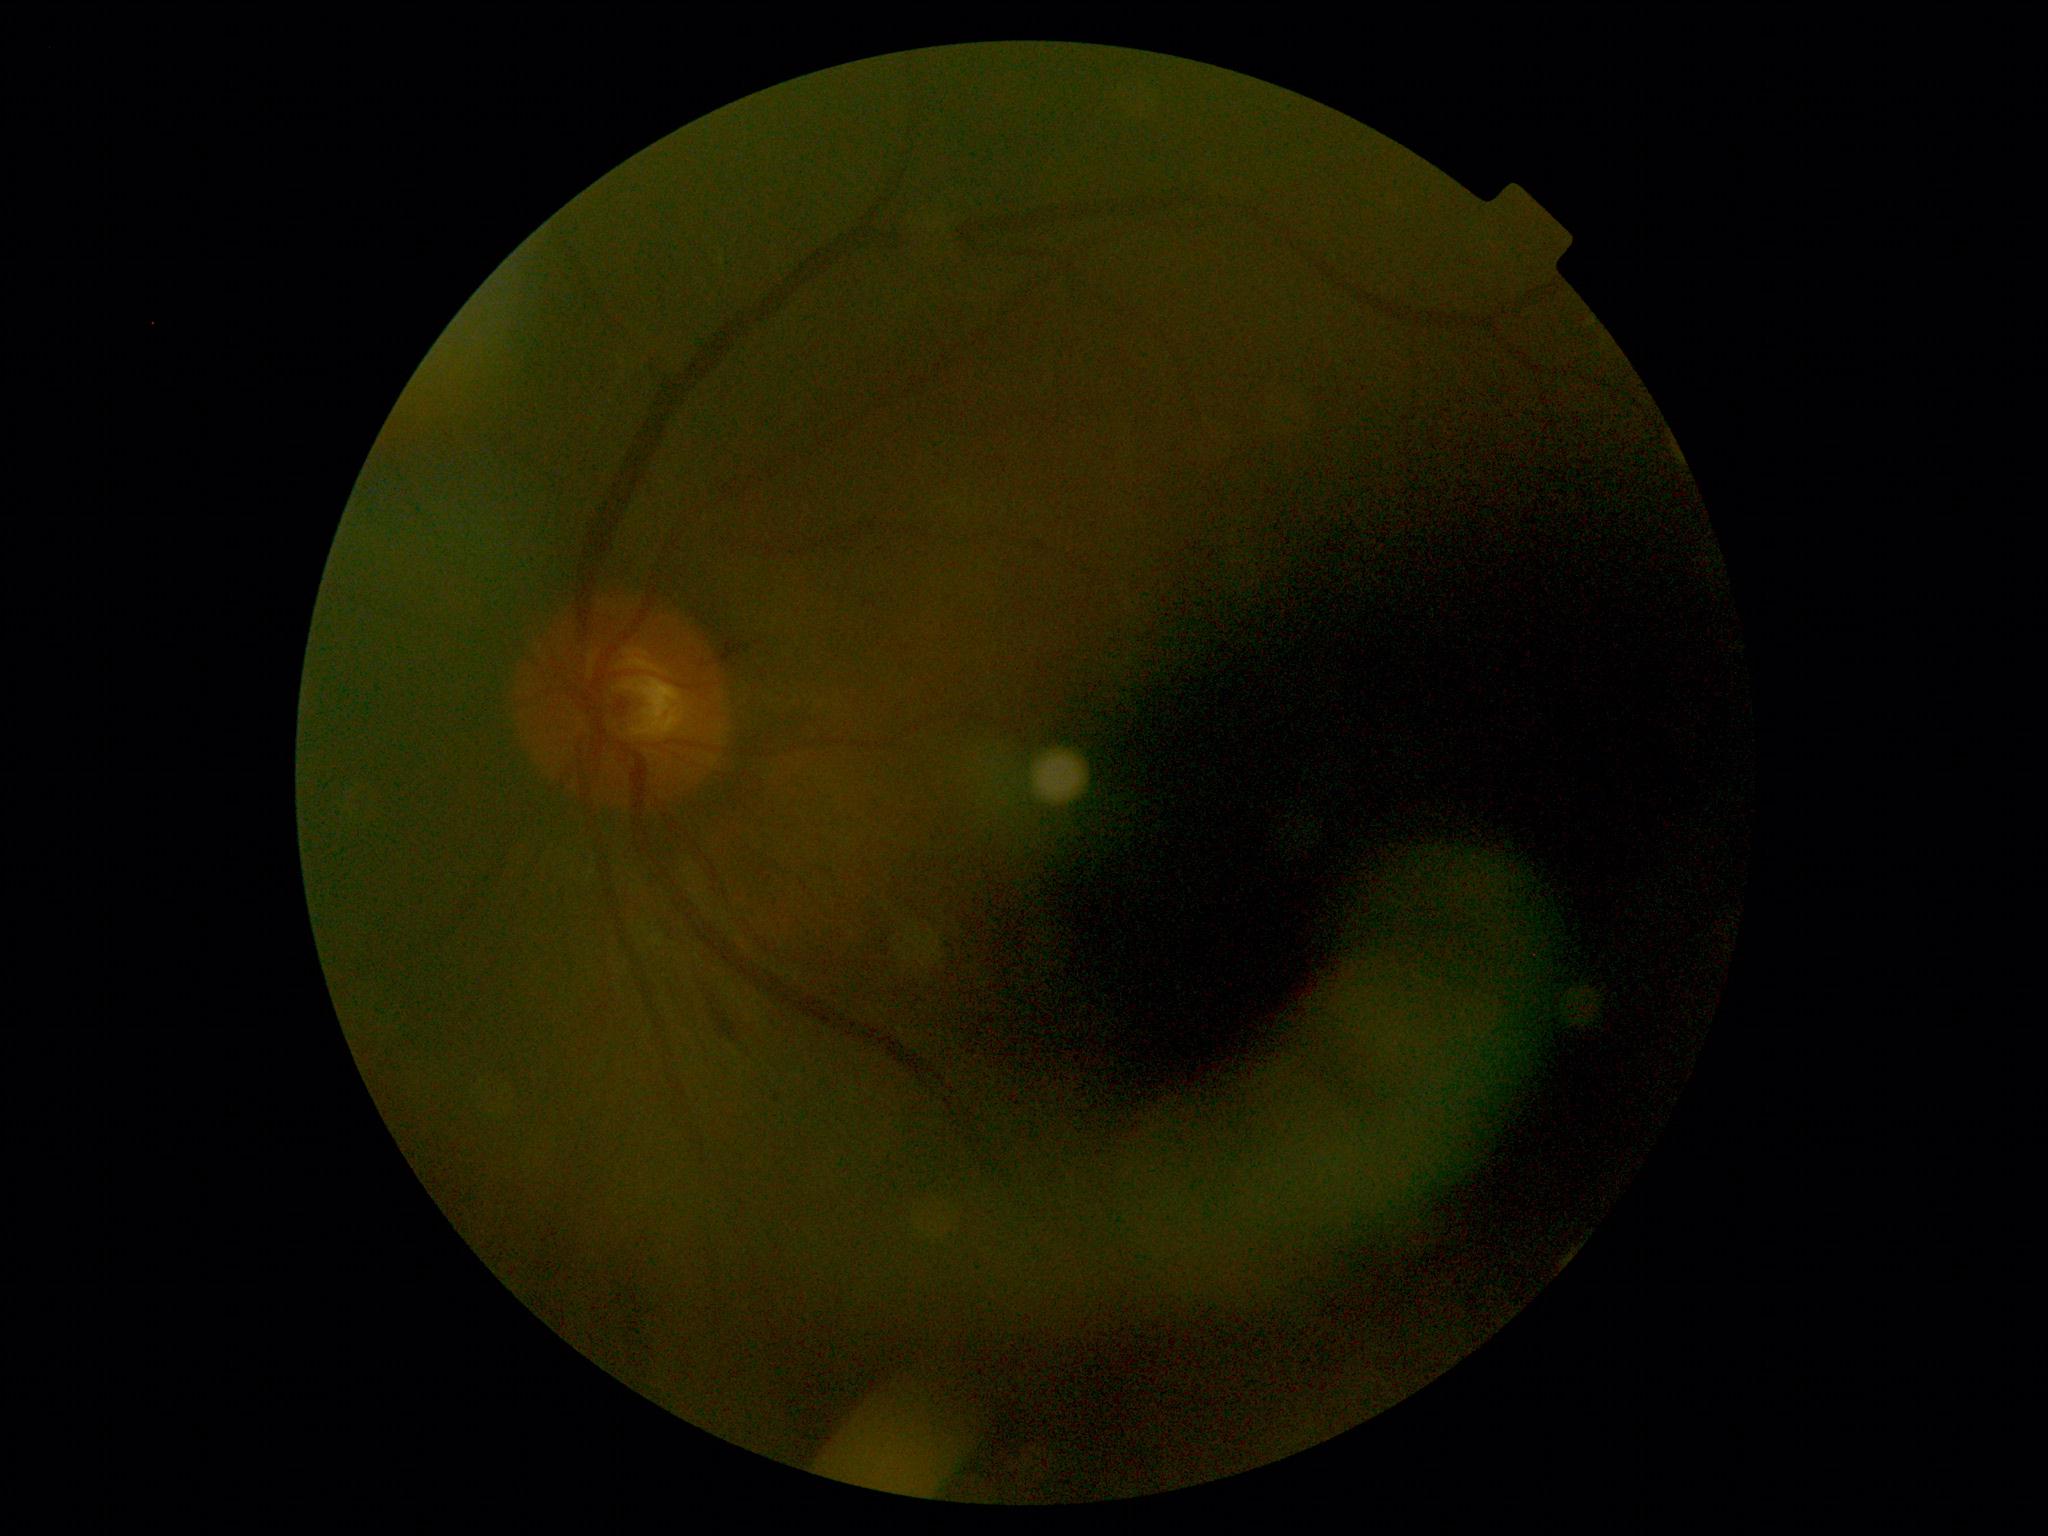
dr_grade: 2/4